CFP, 2352 by 1568 pixels:
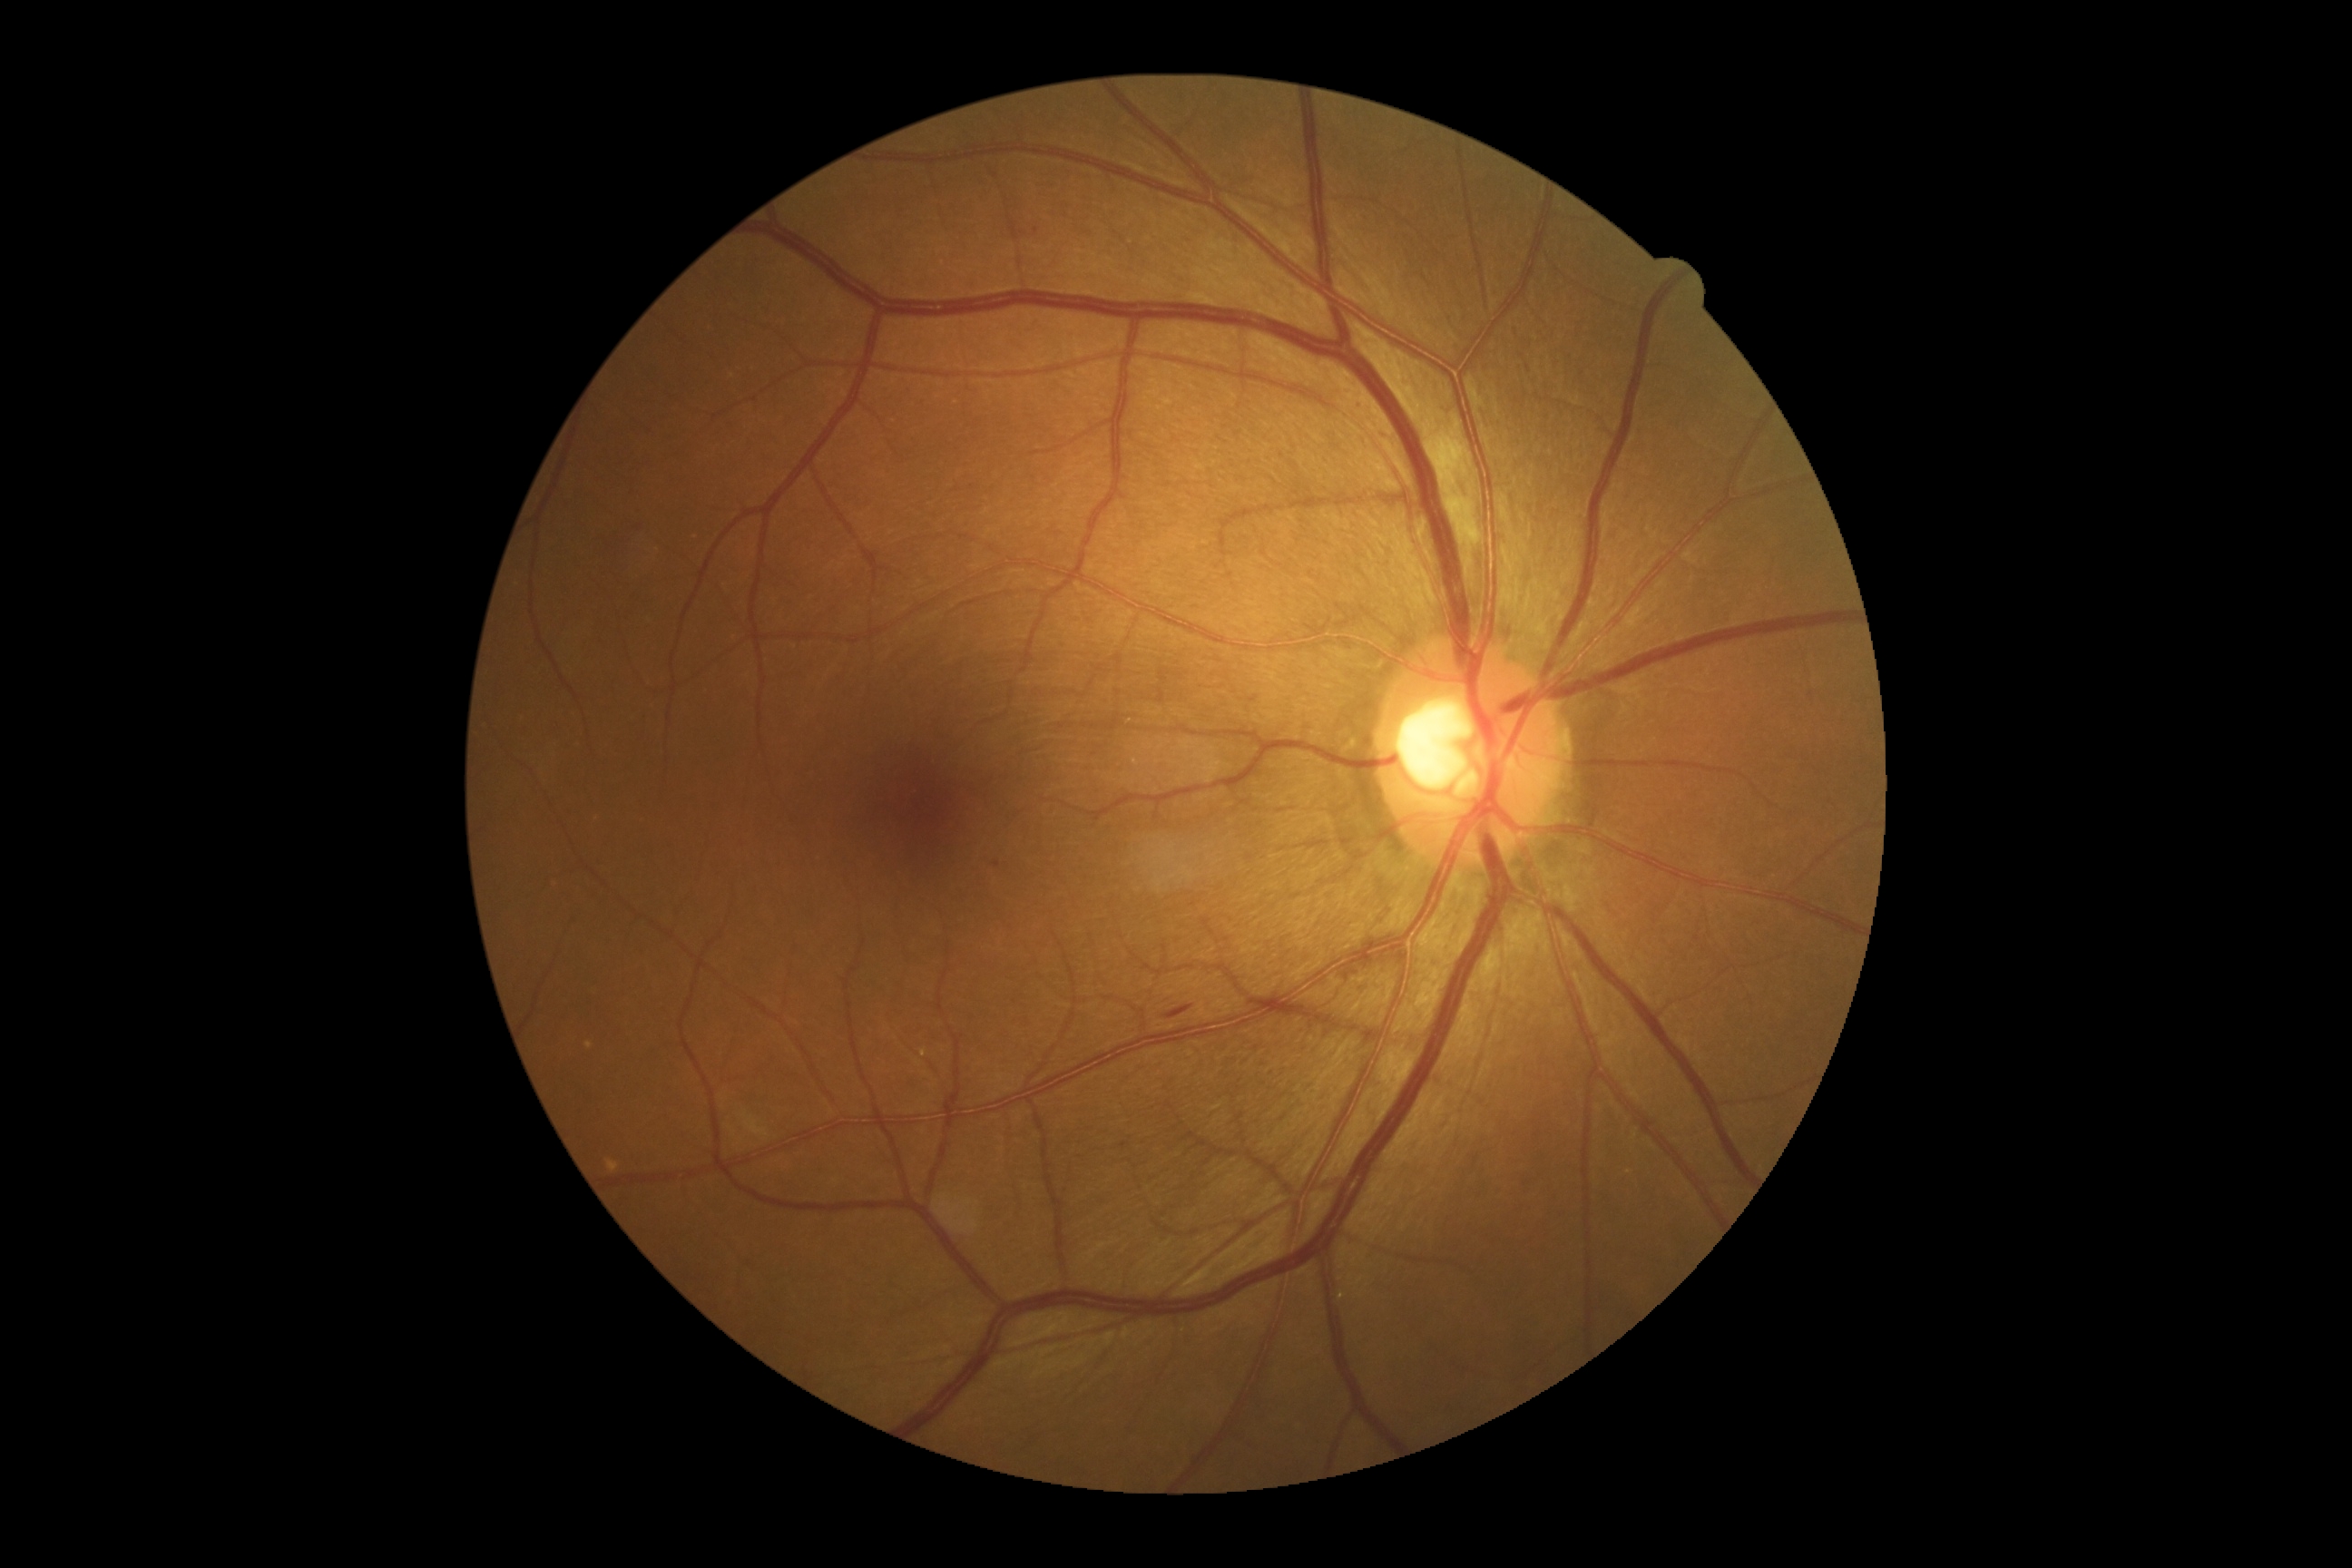

DR class: non-proliferative diabetic retinopathy.
Retinopathy grade is moderate NPDR (2).